2212x1659px · color fundus photograph · 45° field of view — 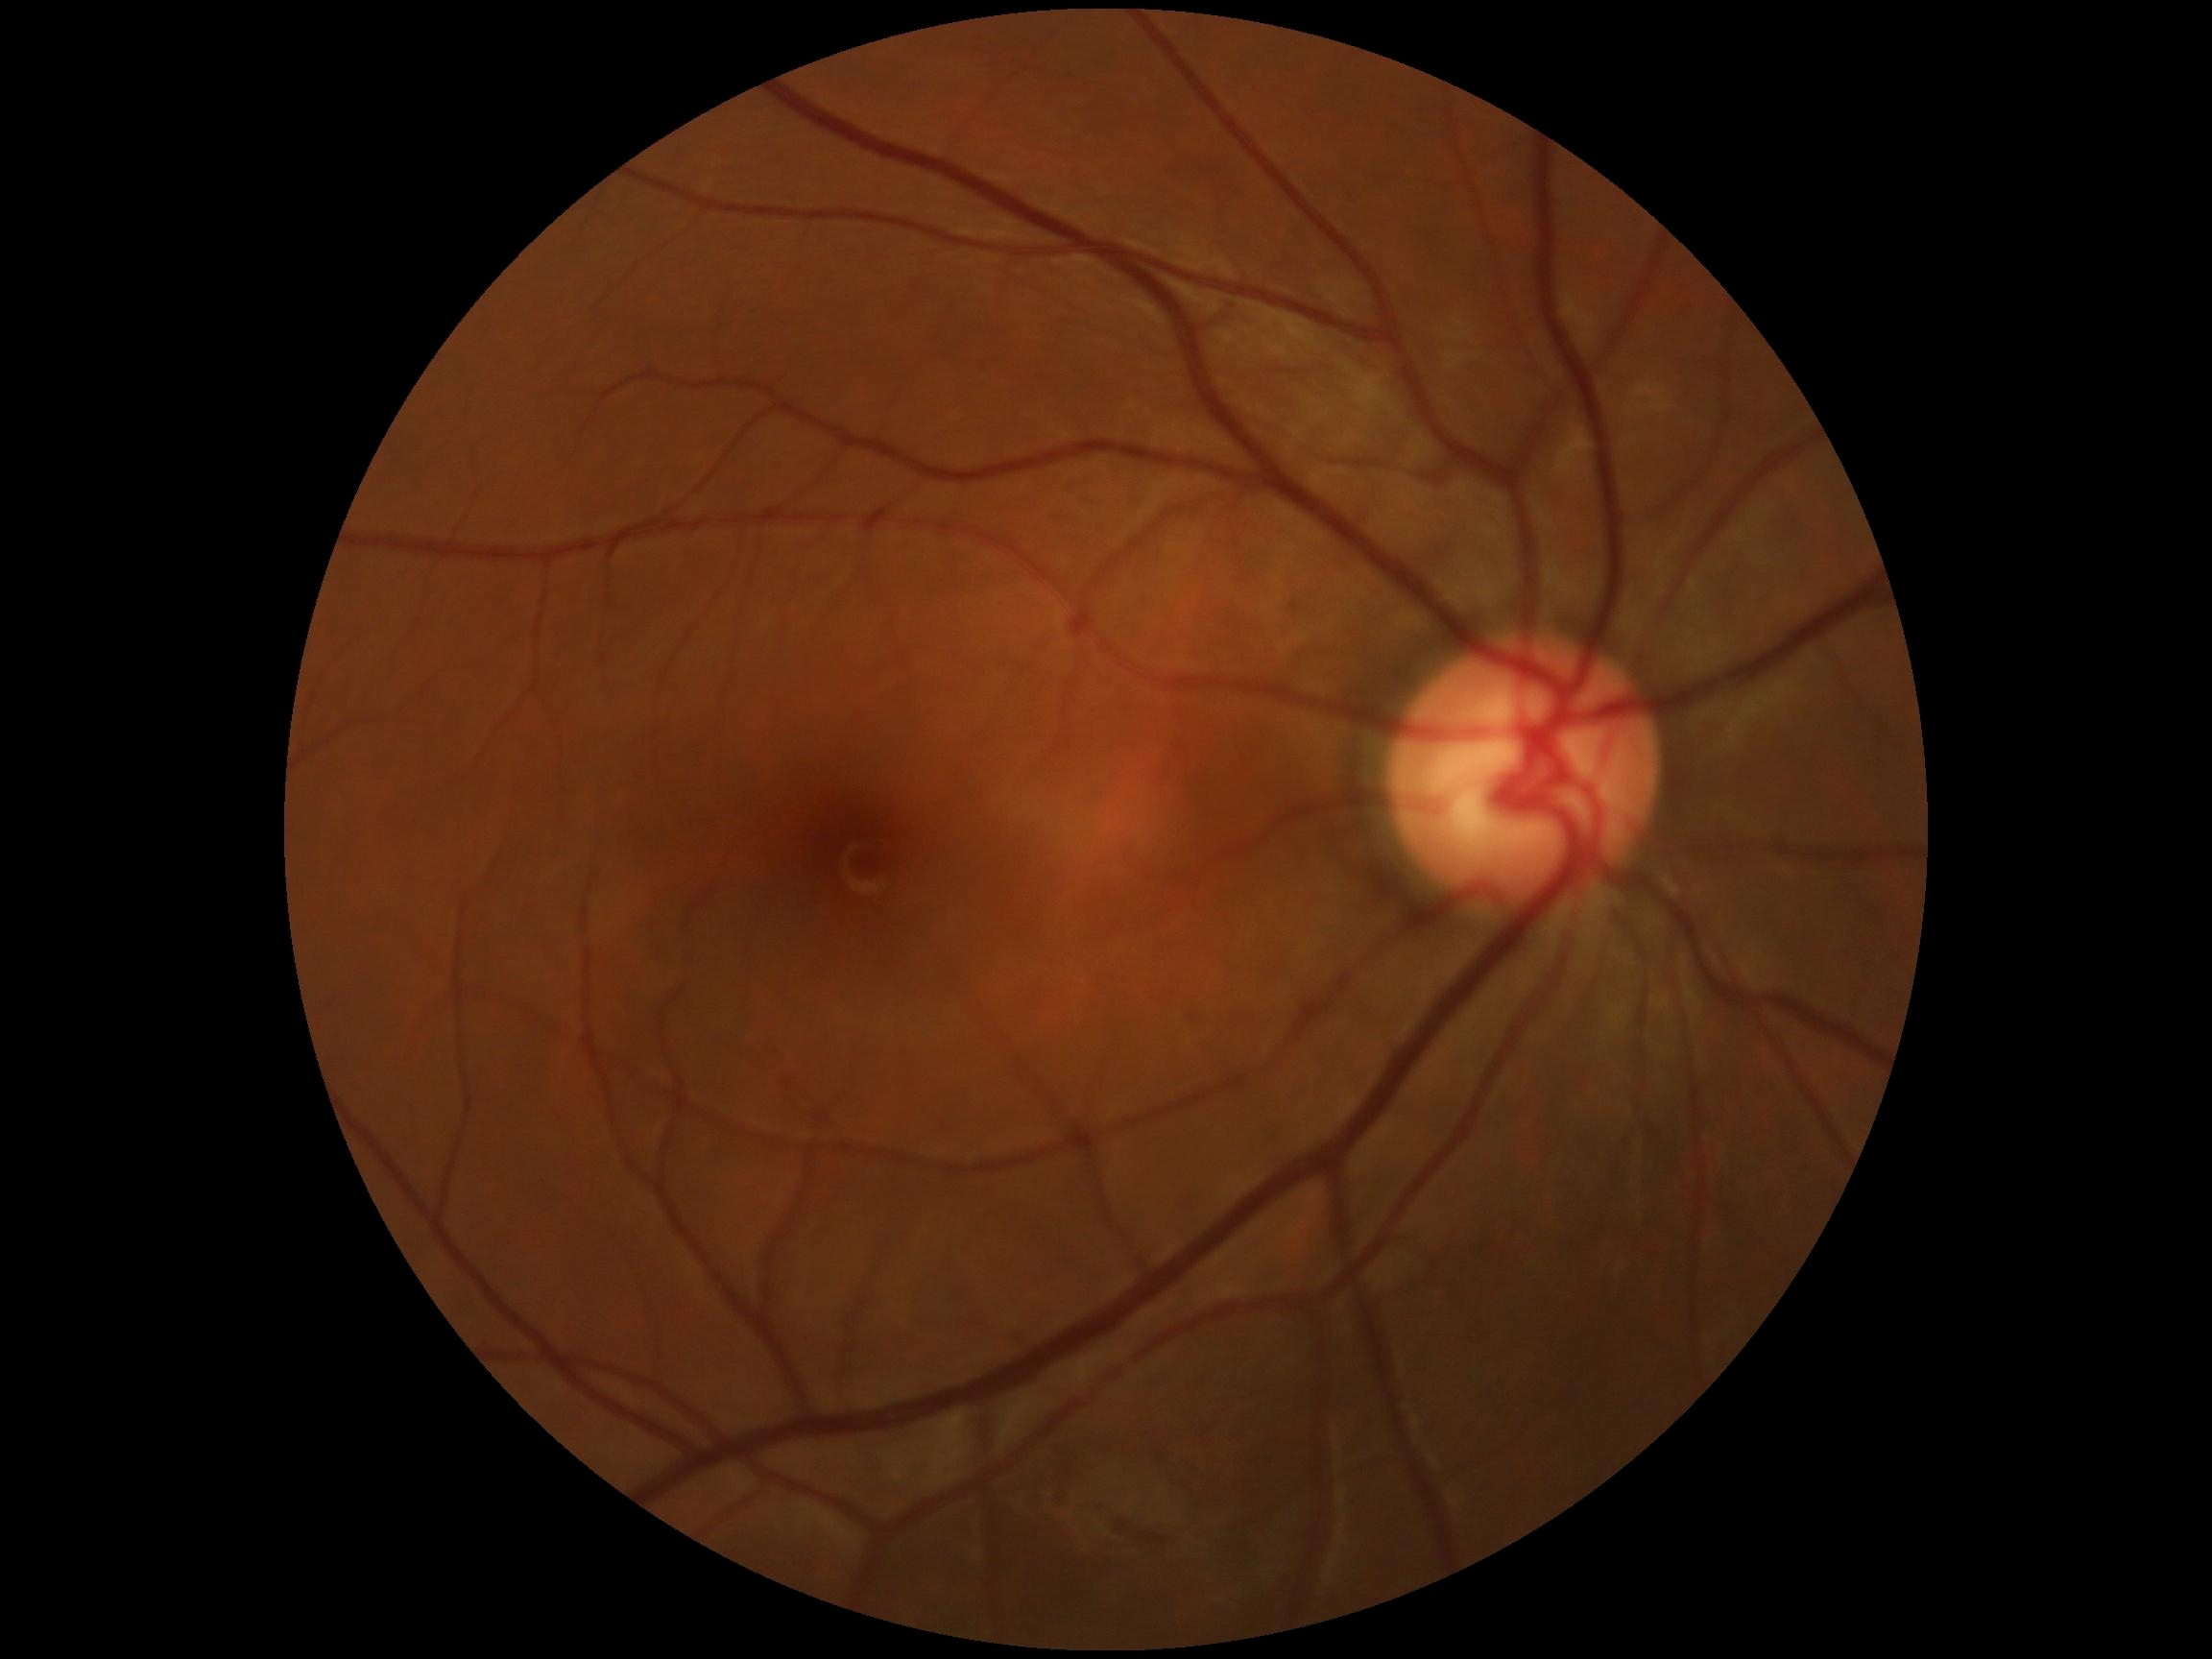

diabetic retinopathy (DR) = grade 0 (no apparent retinopathy)